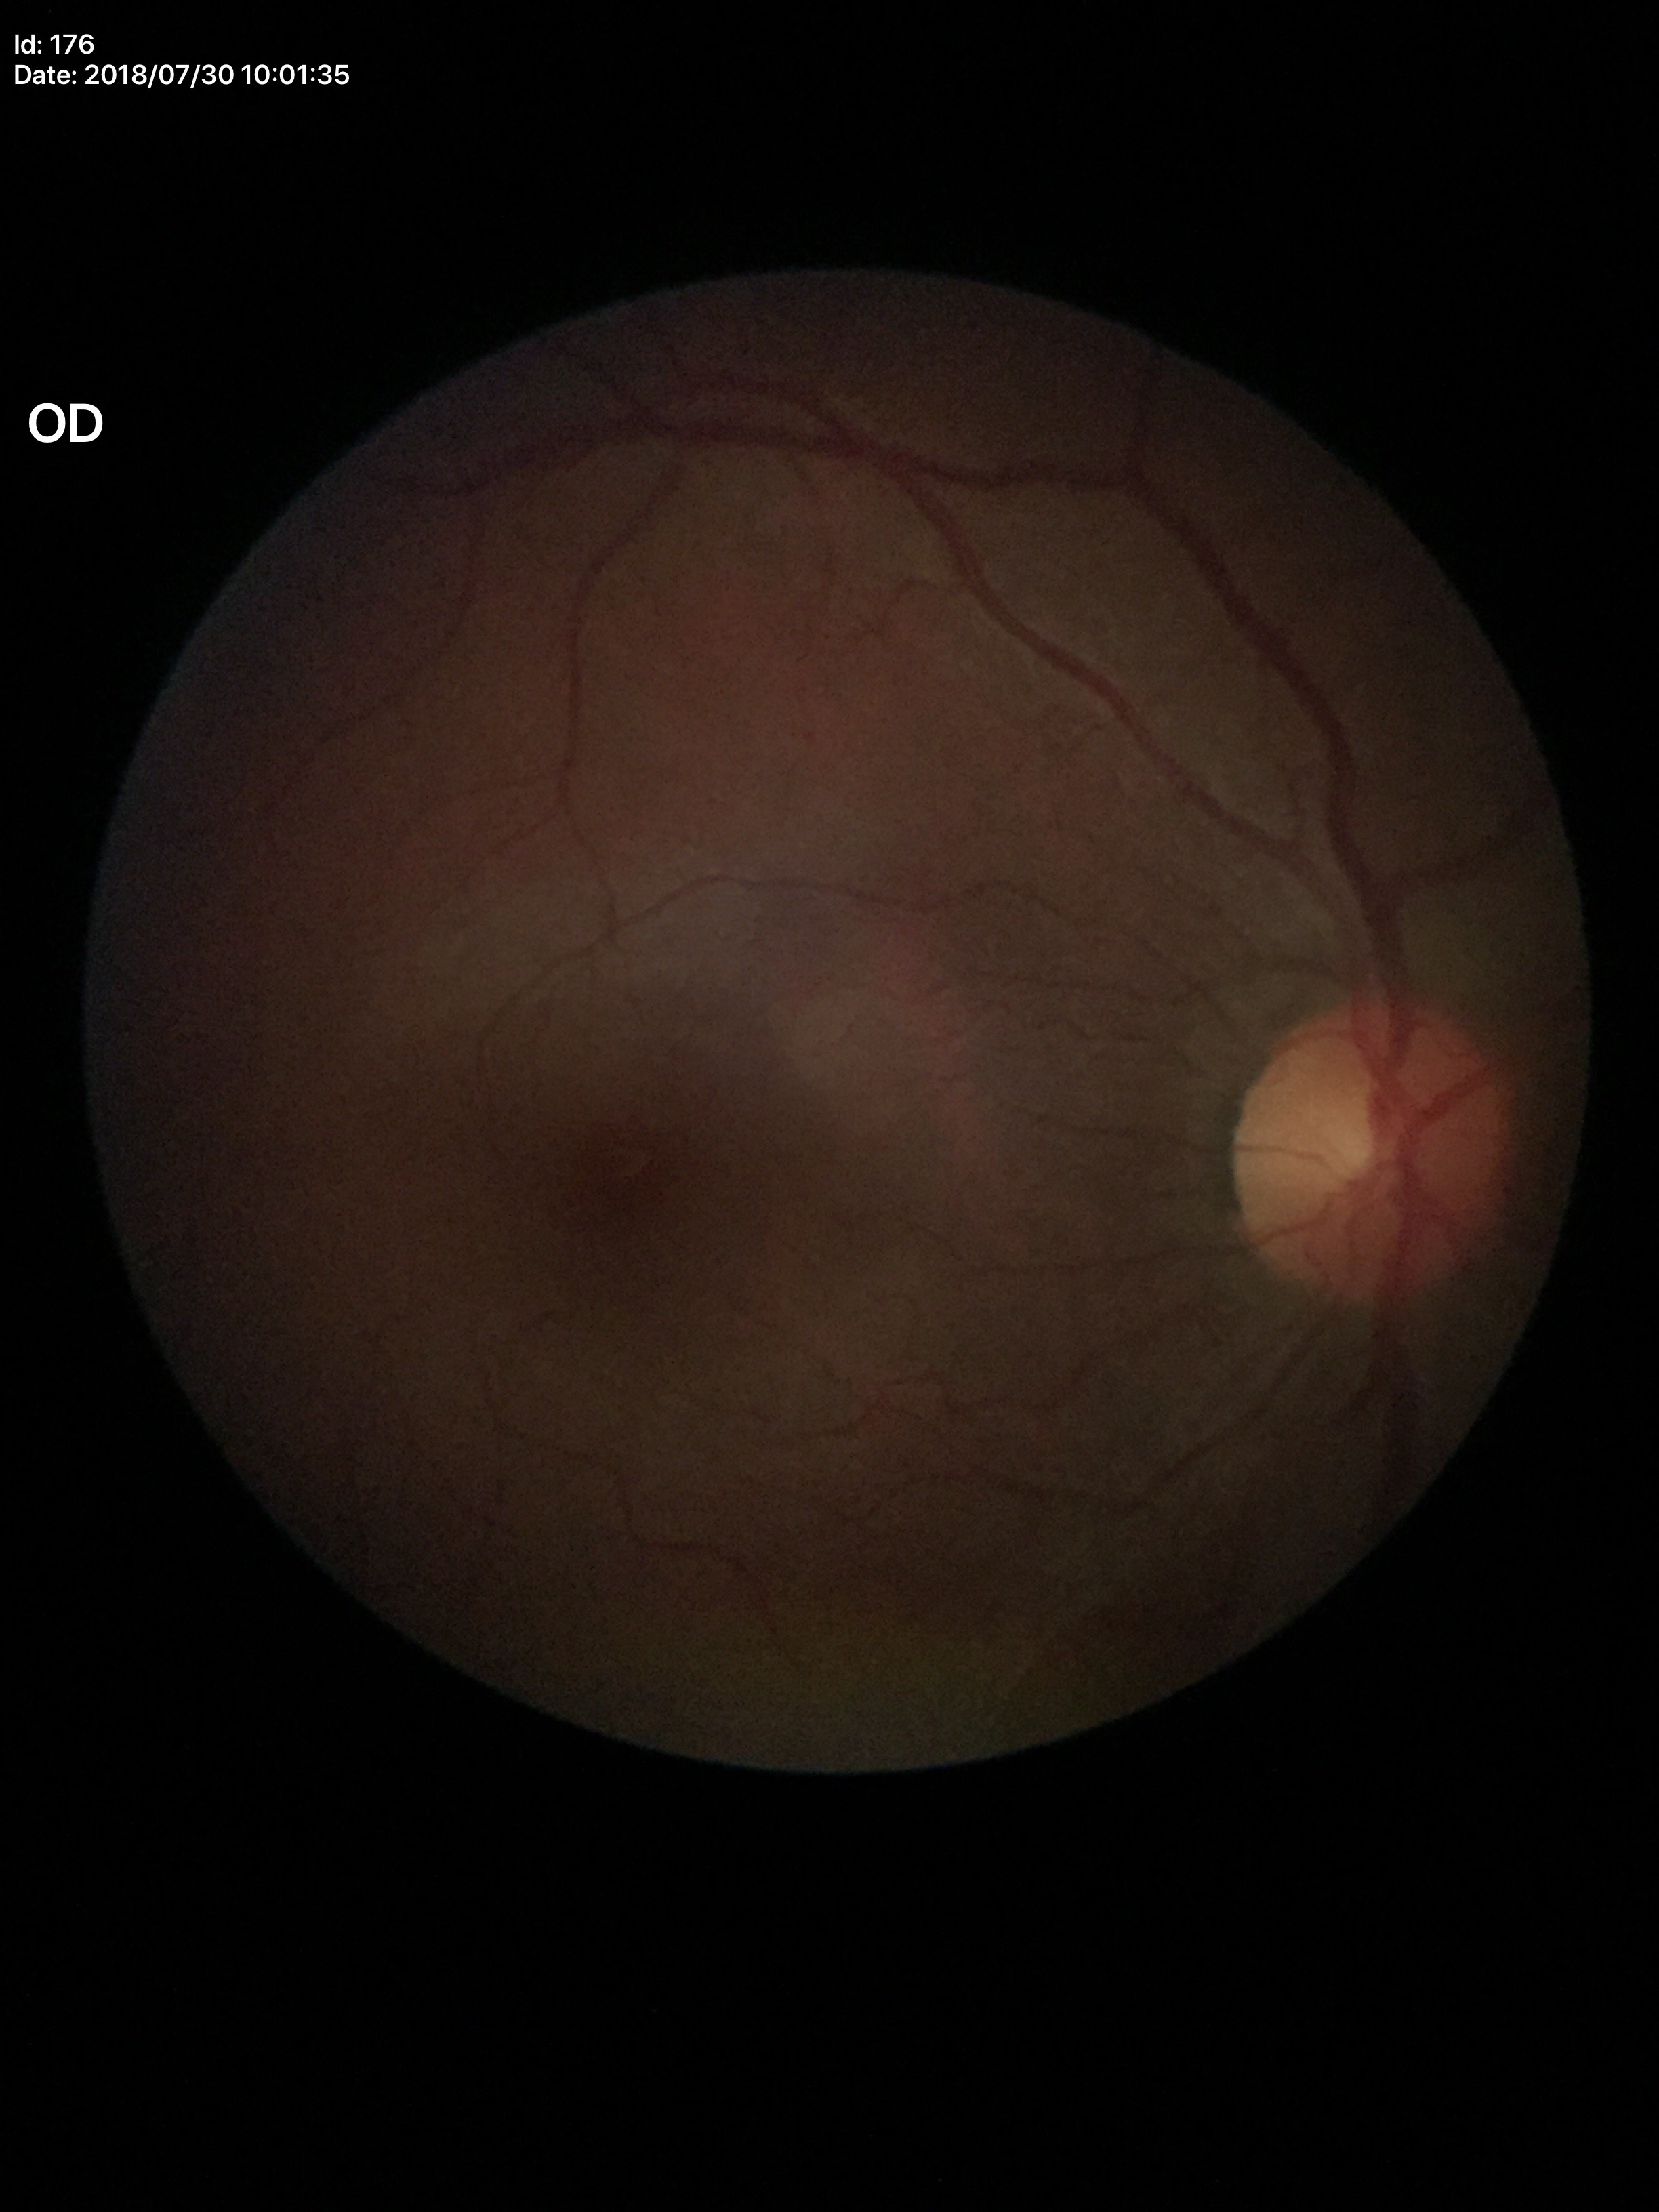

Glaucoma evaluation: no suspicious findings (all 5 graders called normal).
Vertical cup-disc ratio of 0.45.
Area cup-disc ratio of 0.19.
Horizontal CDR is 0.43.